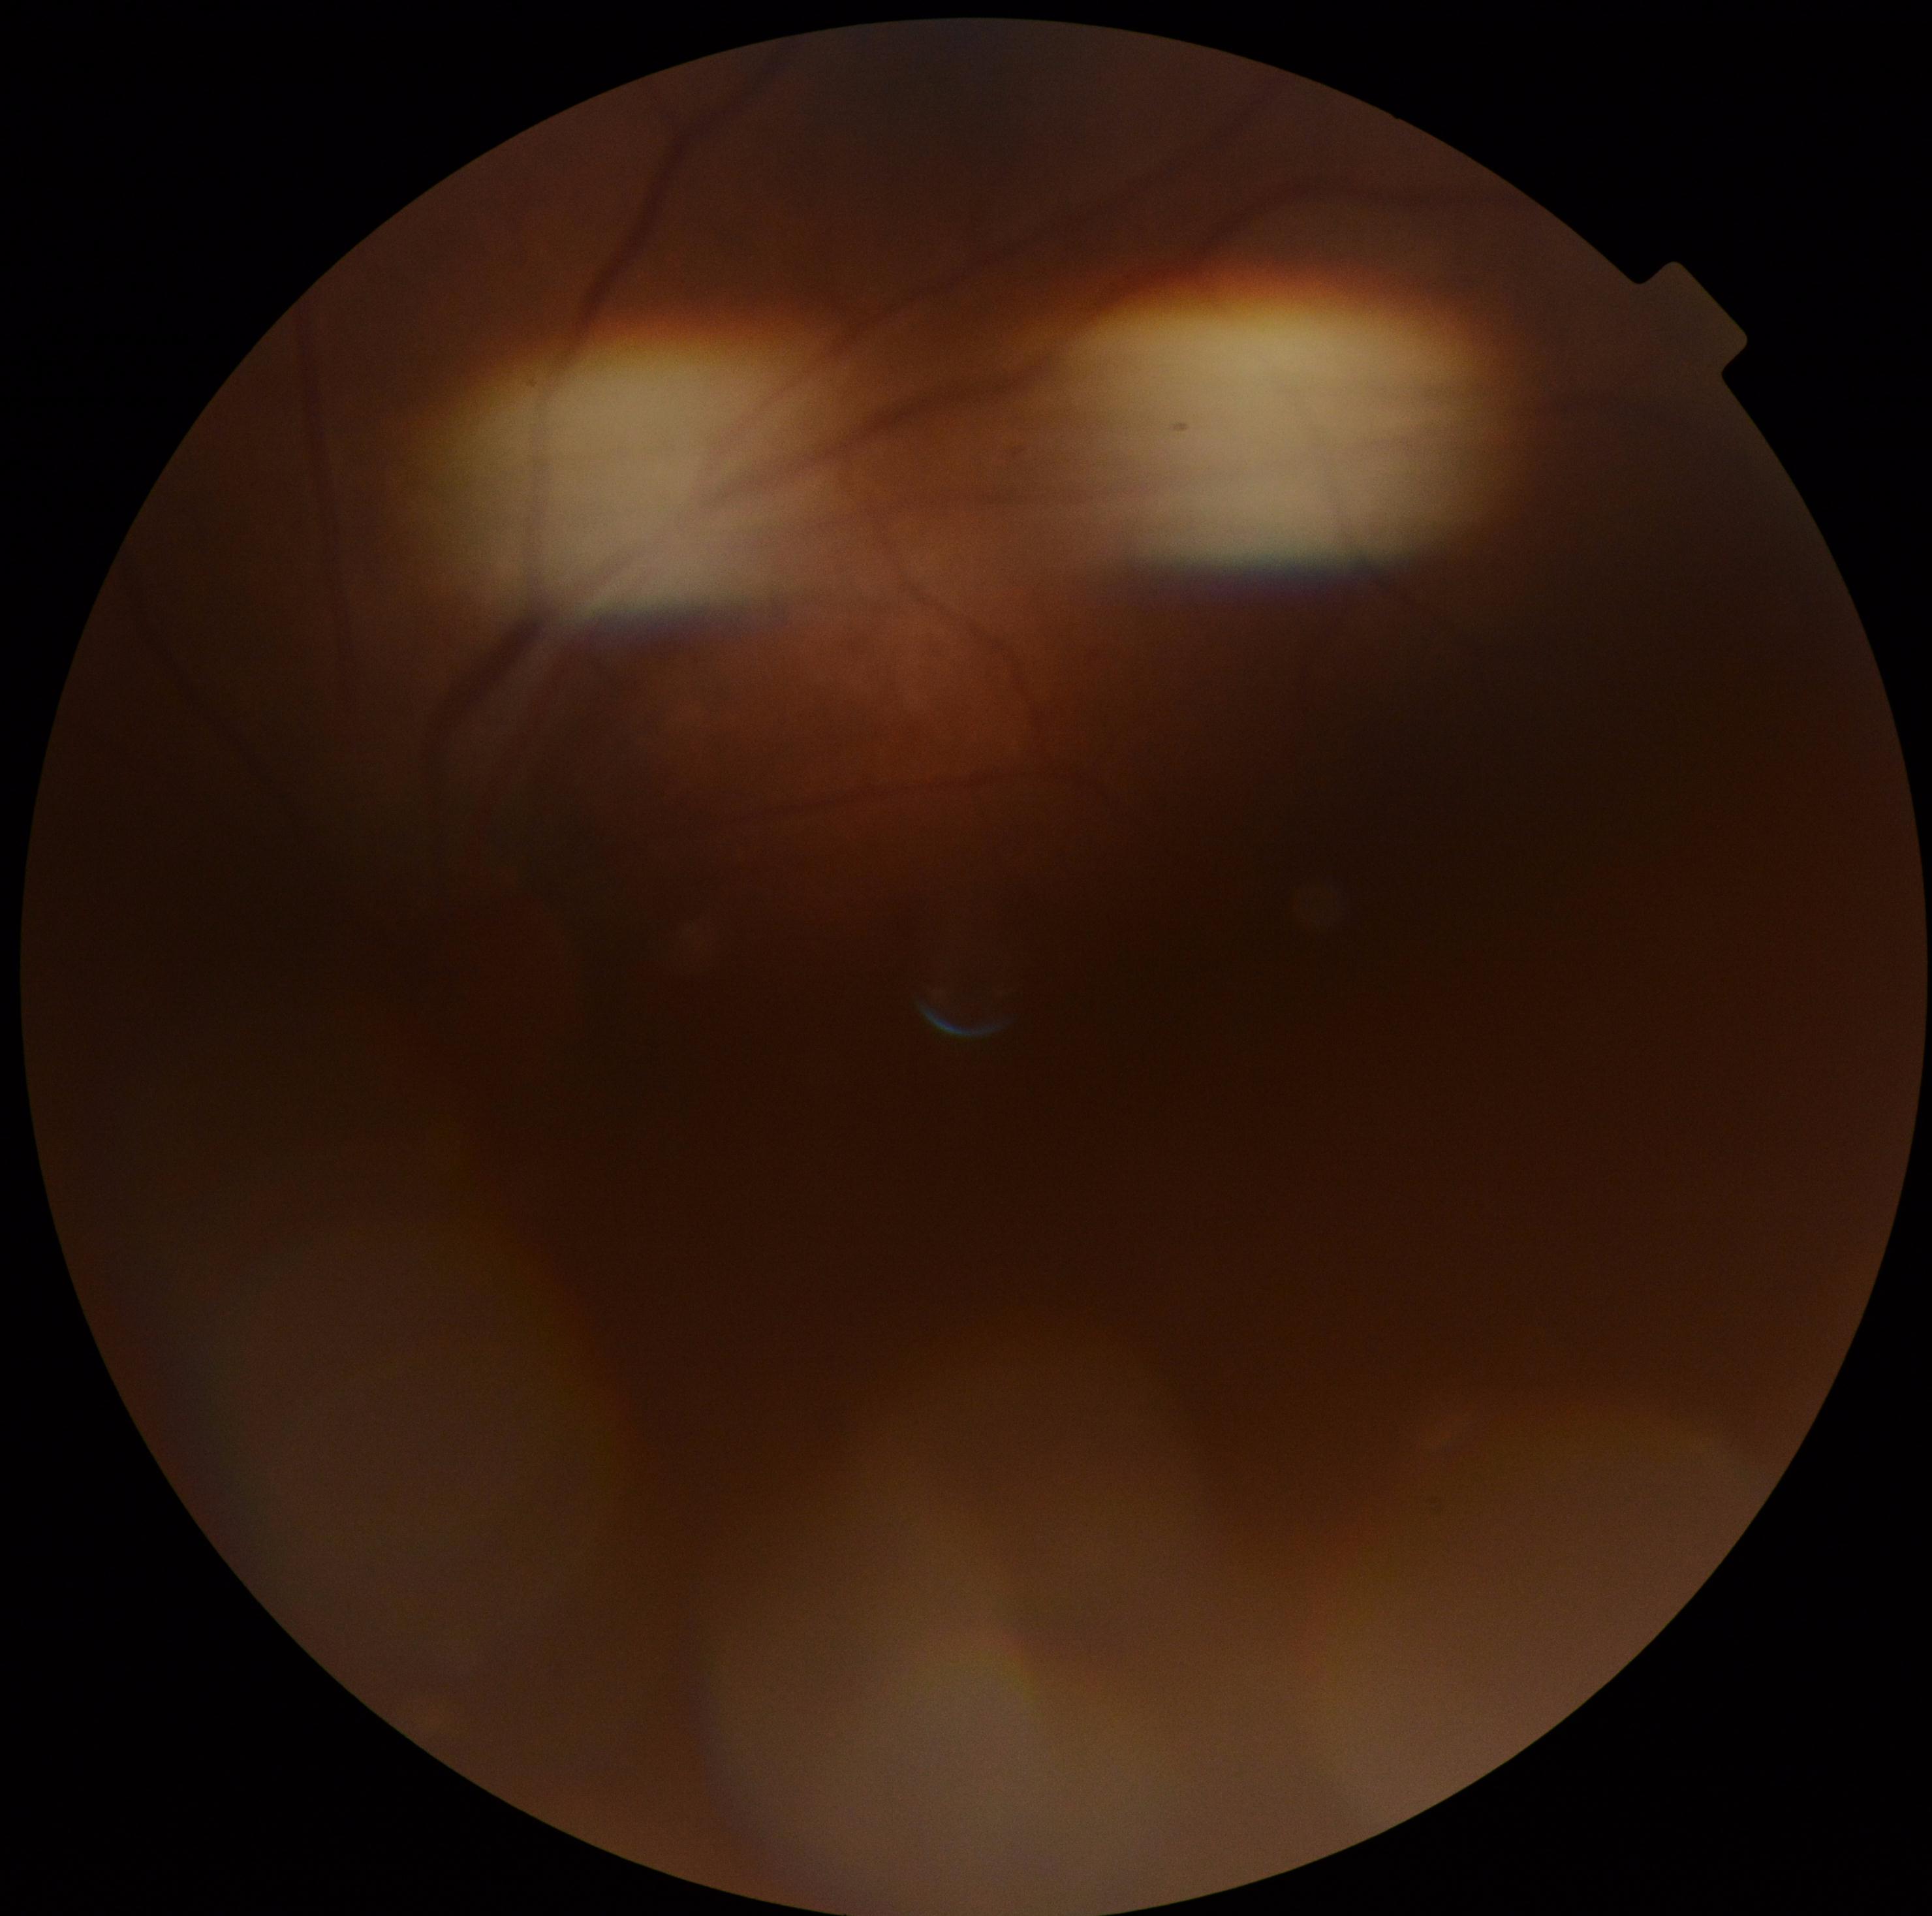

Findings:
– retinopathy grade: ungradable due to poor image quality
– image quality: too poor for DR grading